848x848px.
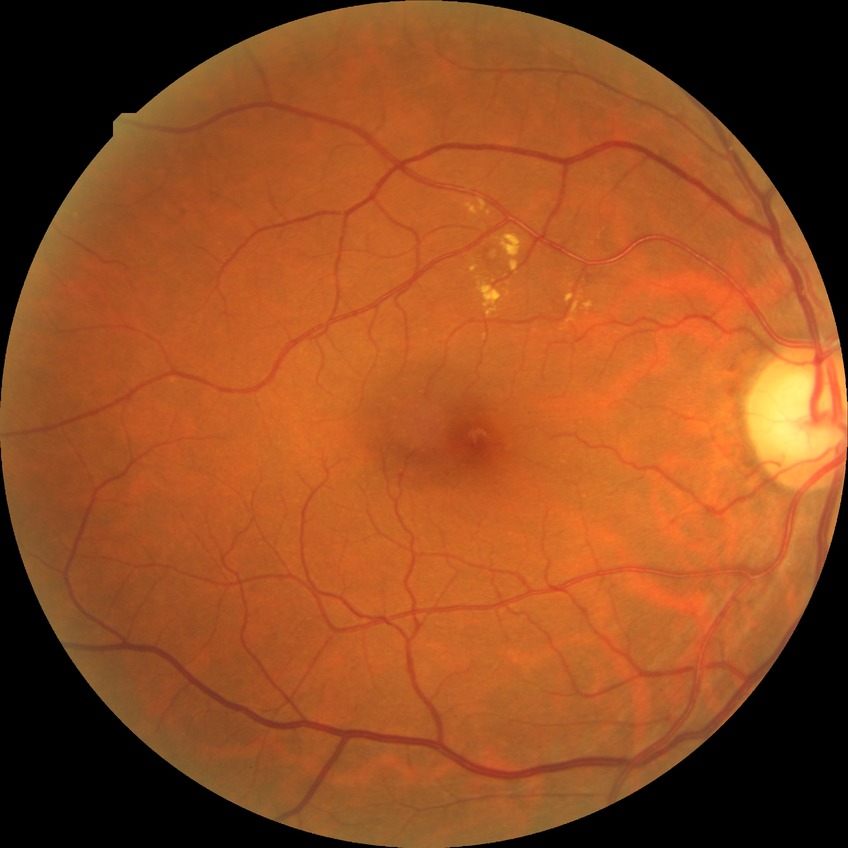
Diabetic retinopathy (DR) is NDR (no diabetic retinopathy).